CFP
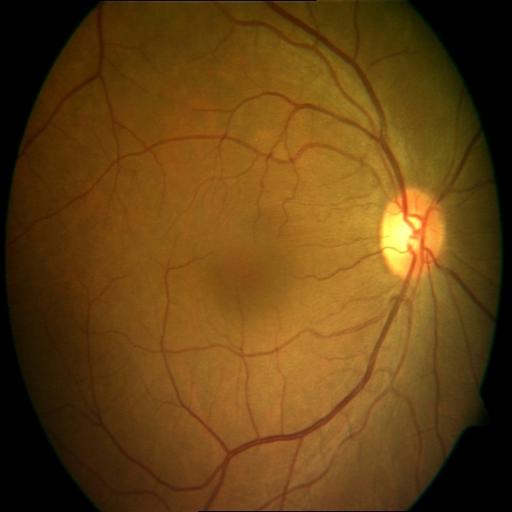
Normal fundus appearance.